Wide-field contact fundus photograph of an infant:
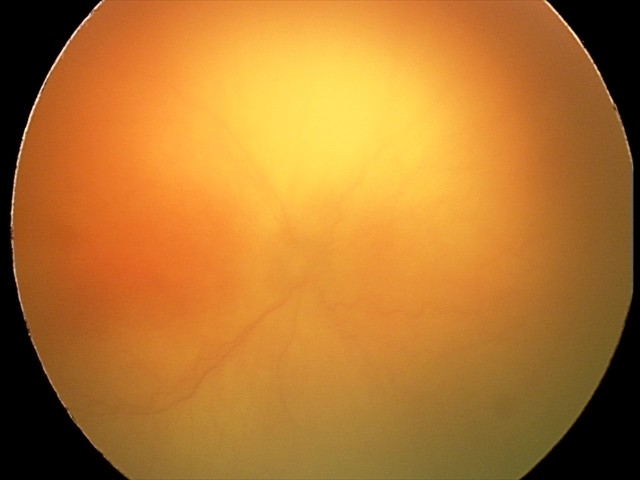

Examination diagnosed as A-ROP (aggressive ROP) — rapidly progressive severe ROP with prominent plus disease, often without classic stage progression.